Non-mydriatic; 240 x 240 pixels
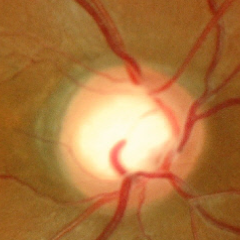

Fundus appearance consistent with no glaucomatous optic neuropathy.